Image size 2352x1568, color fundus image, 45° field of view — 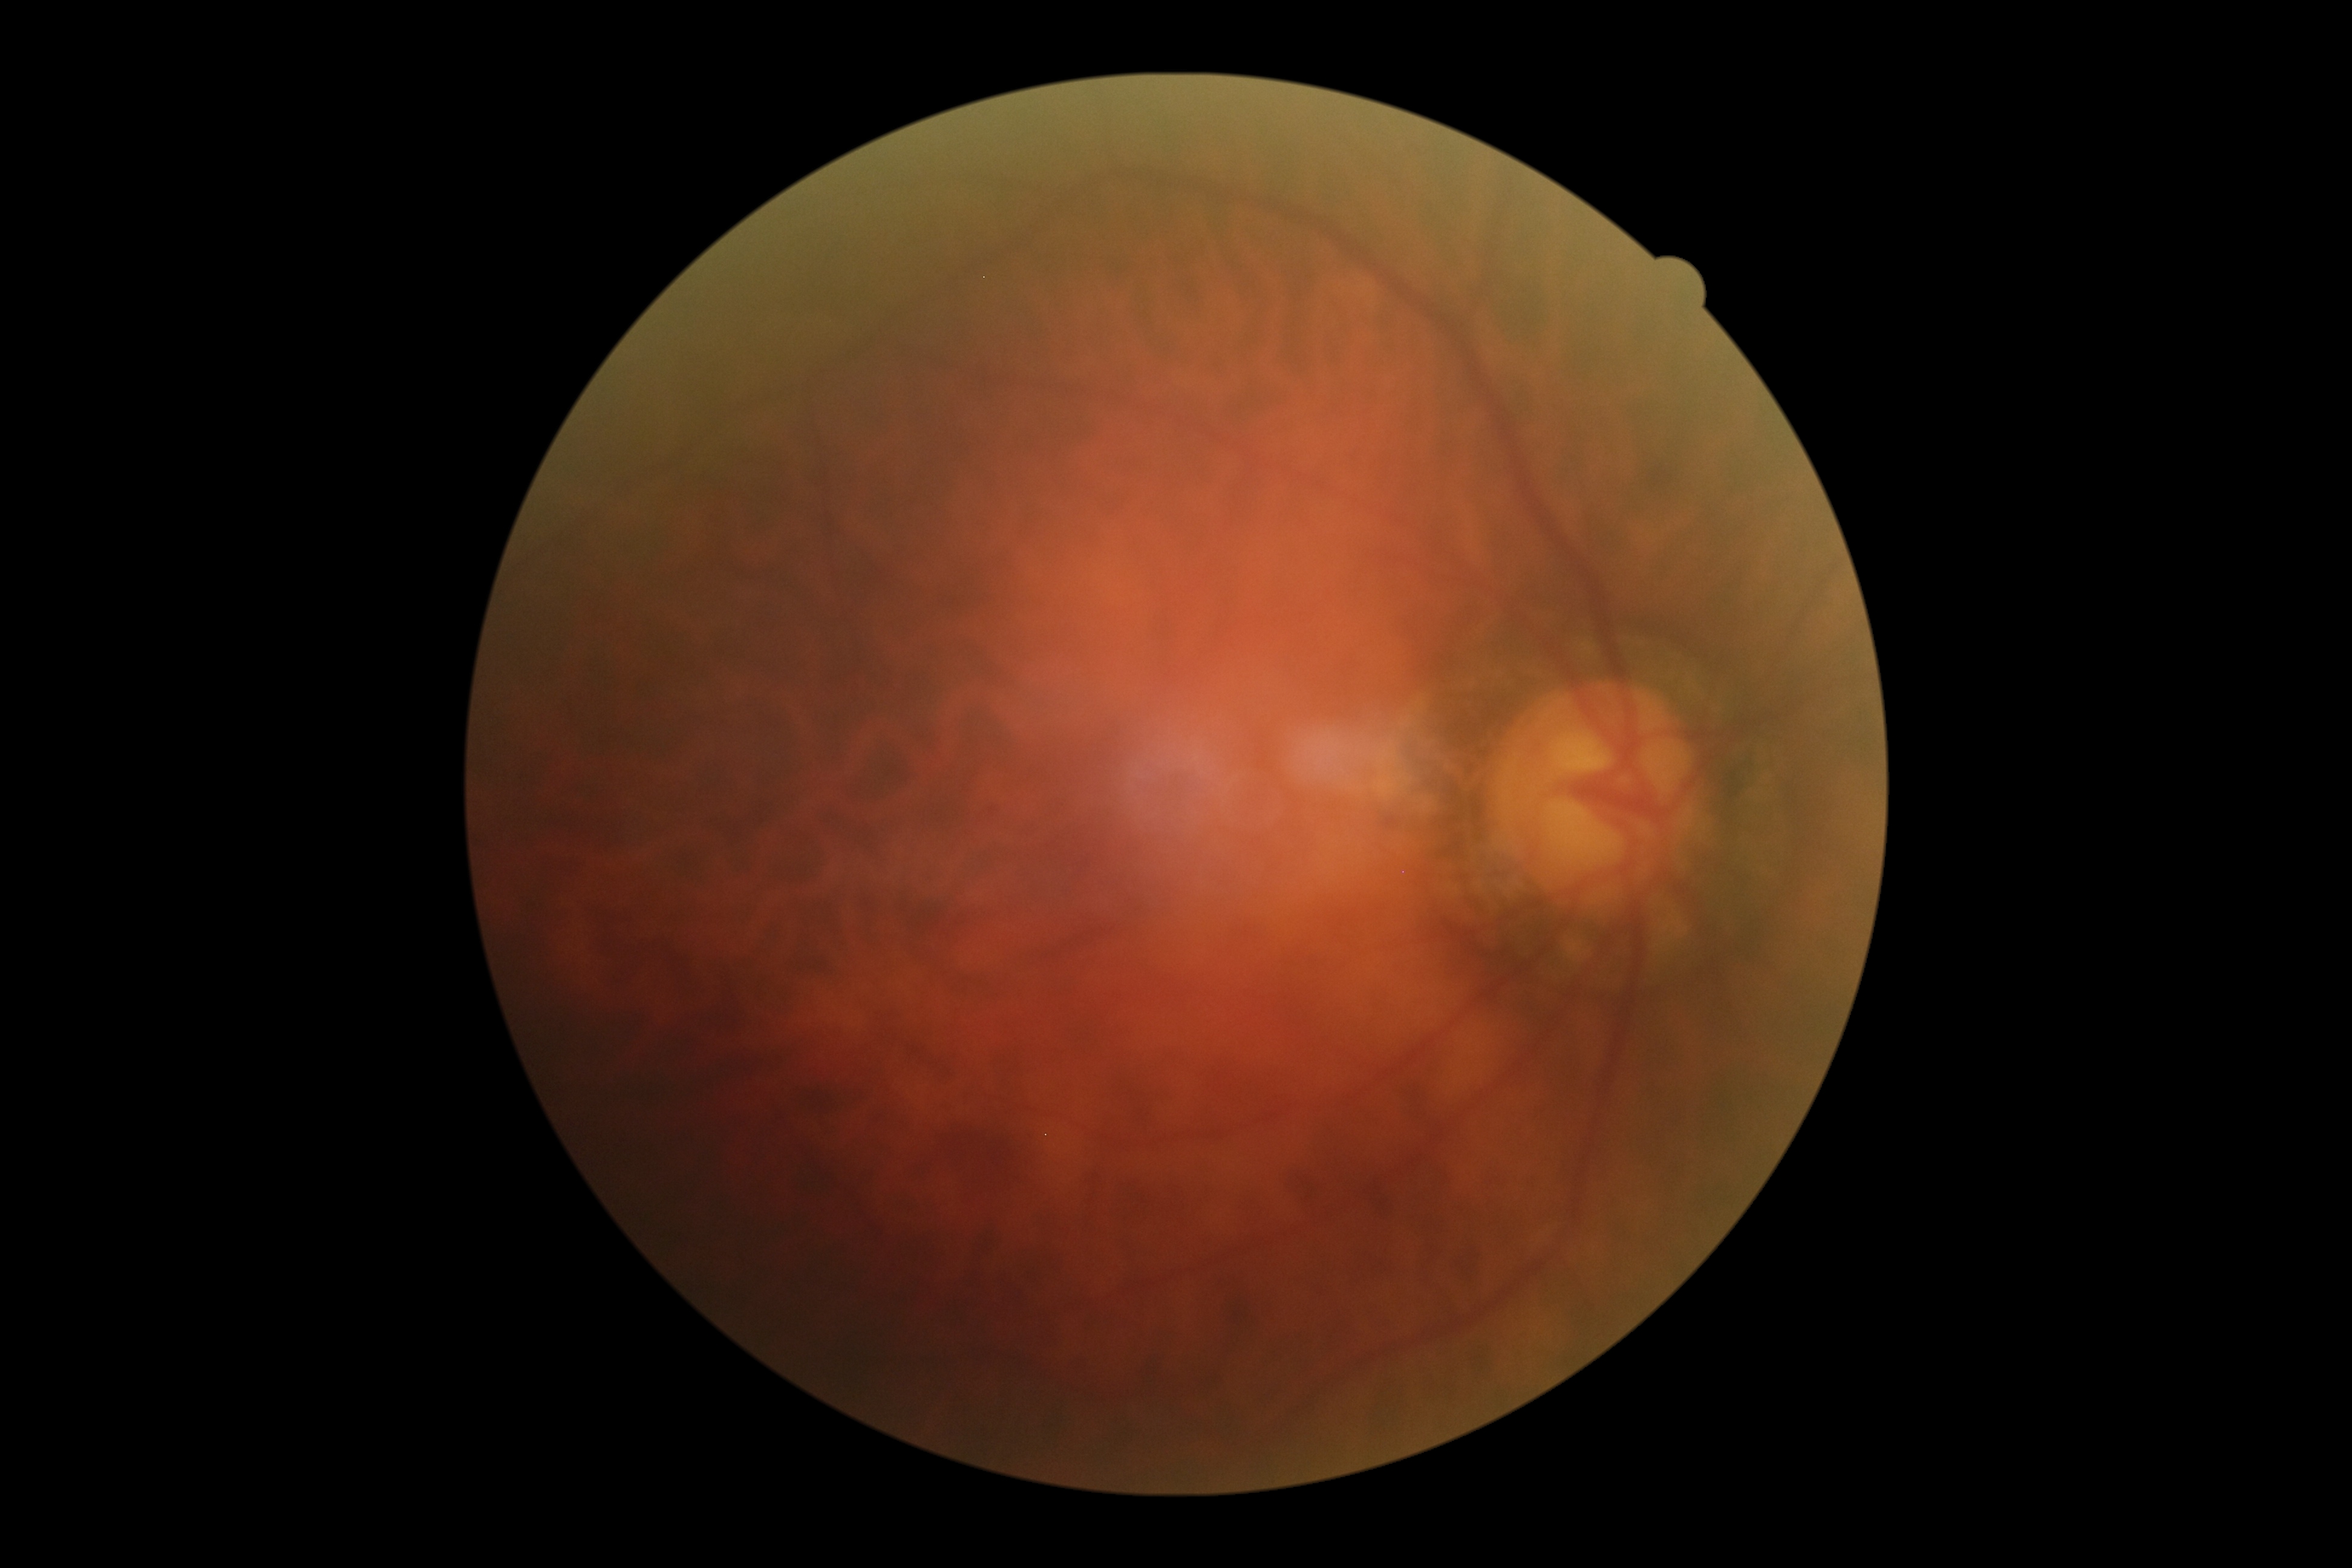
Retinopathy is 0/4 — no visible signs of diabetic retinopathy.